Modified Davis classification:
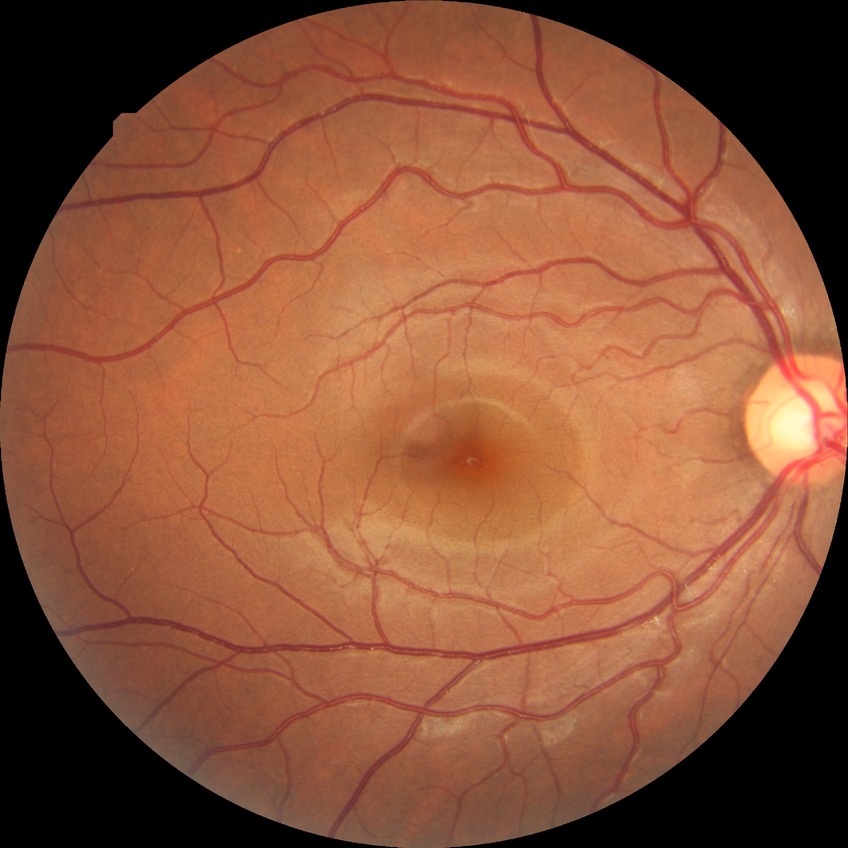
Diabetic retinopathy (DR): no diabetic retinopathy (NDR).